Pediatric wide-field fundus photograph: 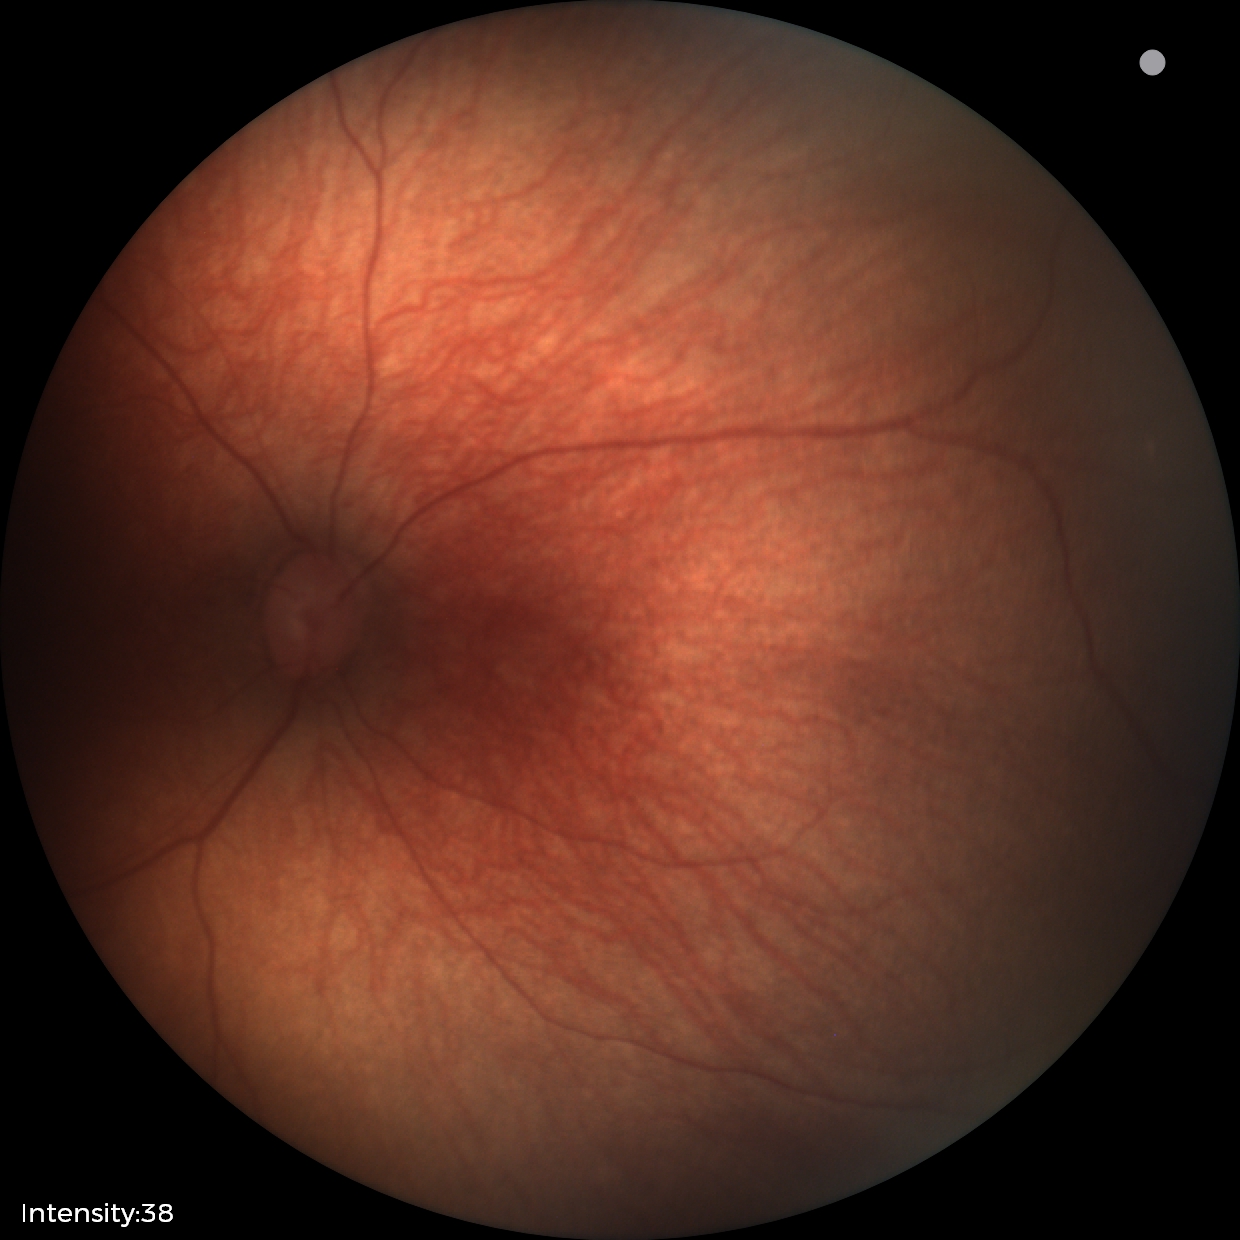 Examination with physiological retinal findings.